Color fundus photograph:
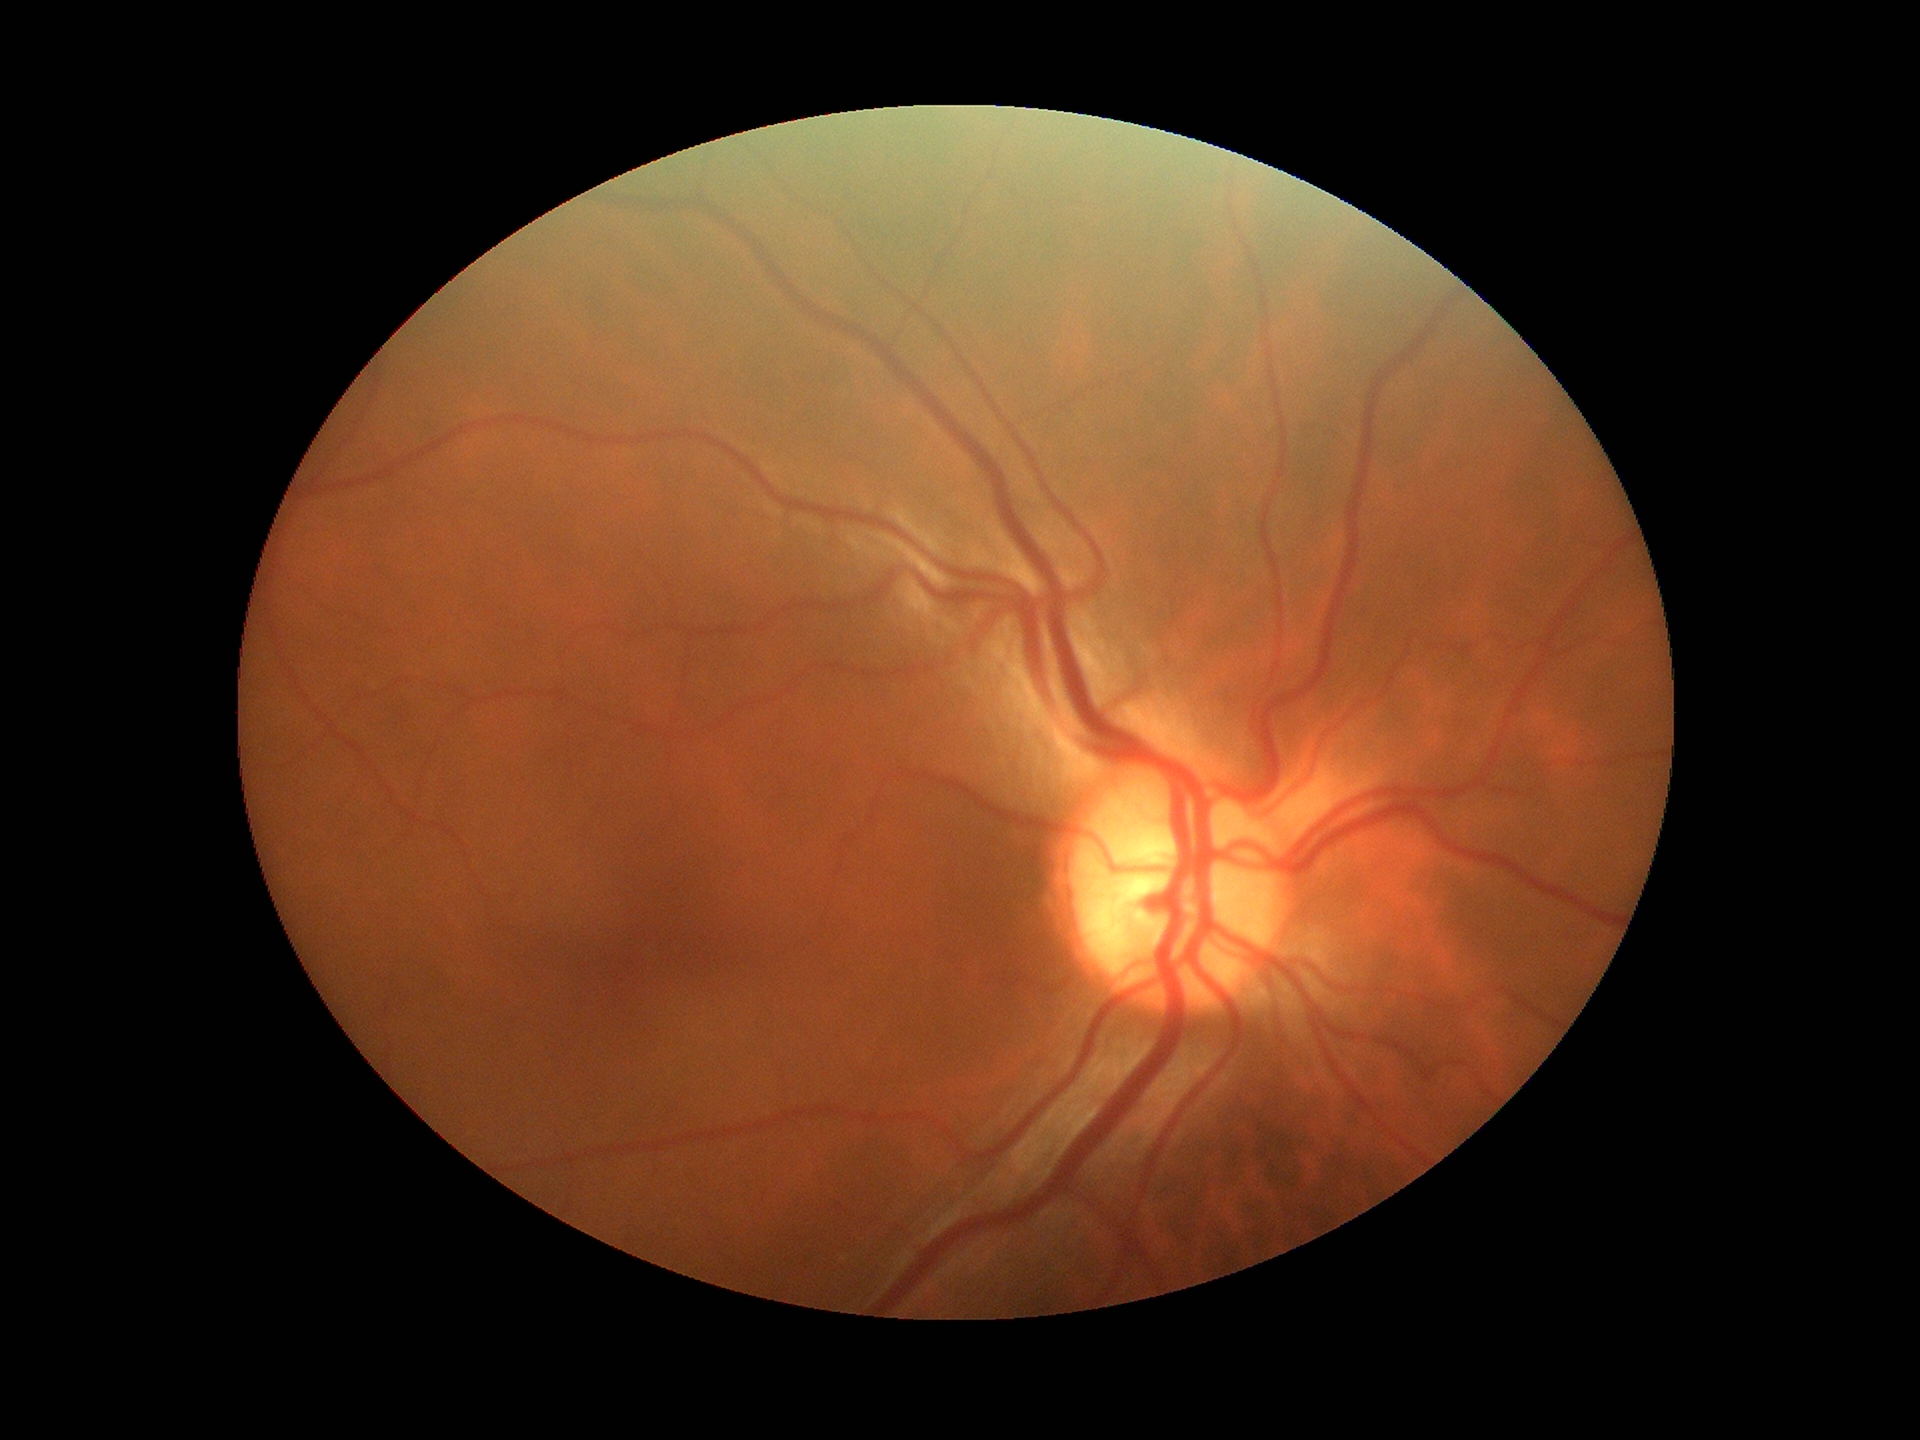
HCDR is 0.53.
Glaucoma impression: negative.
VCDR of 0.52.